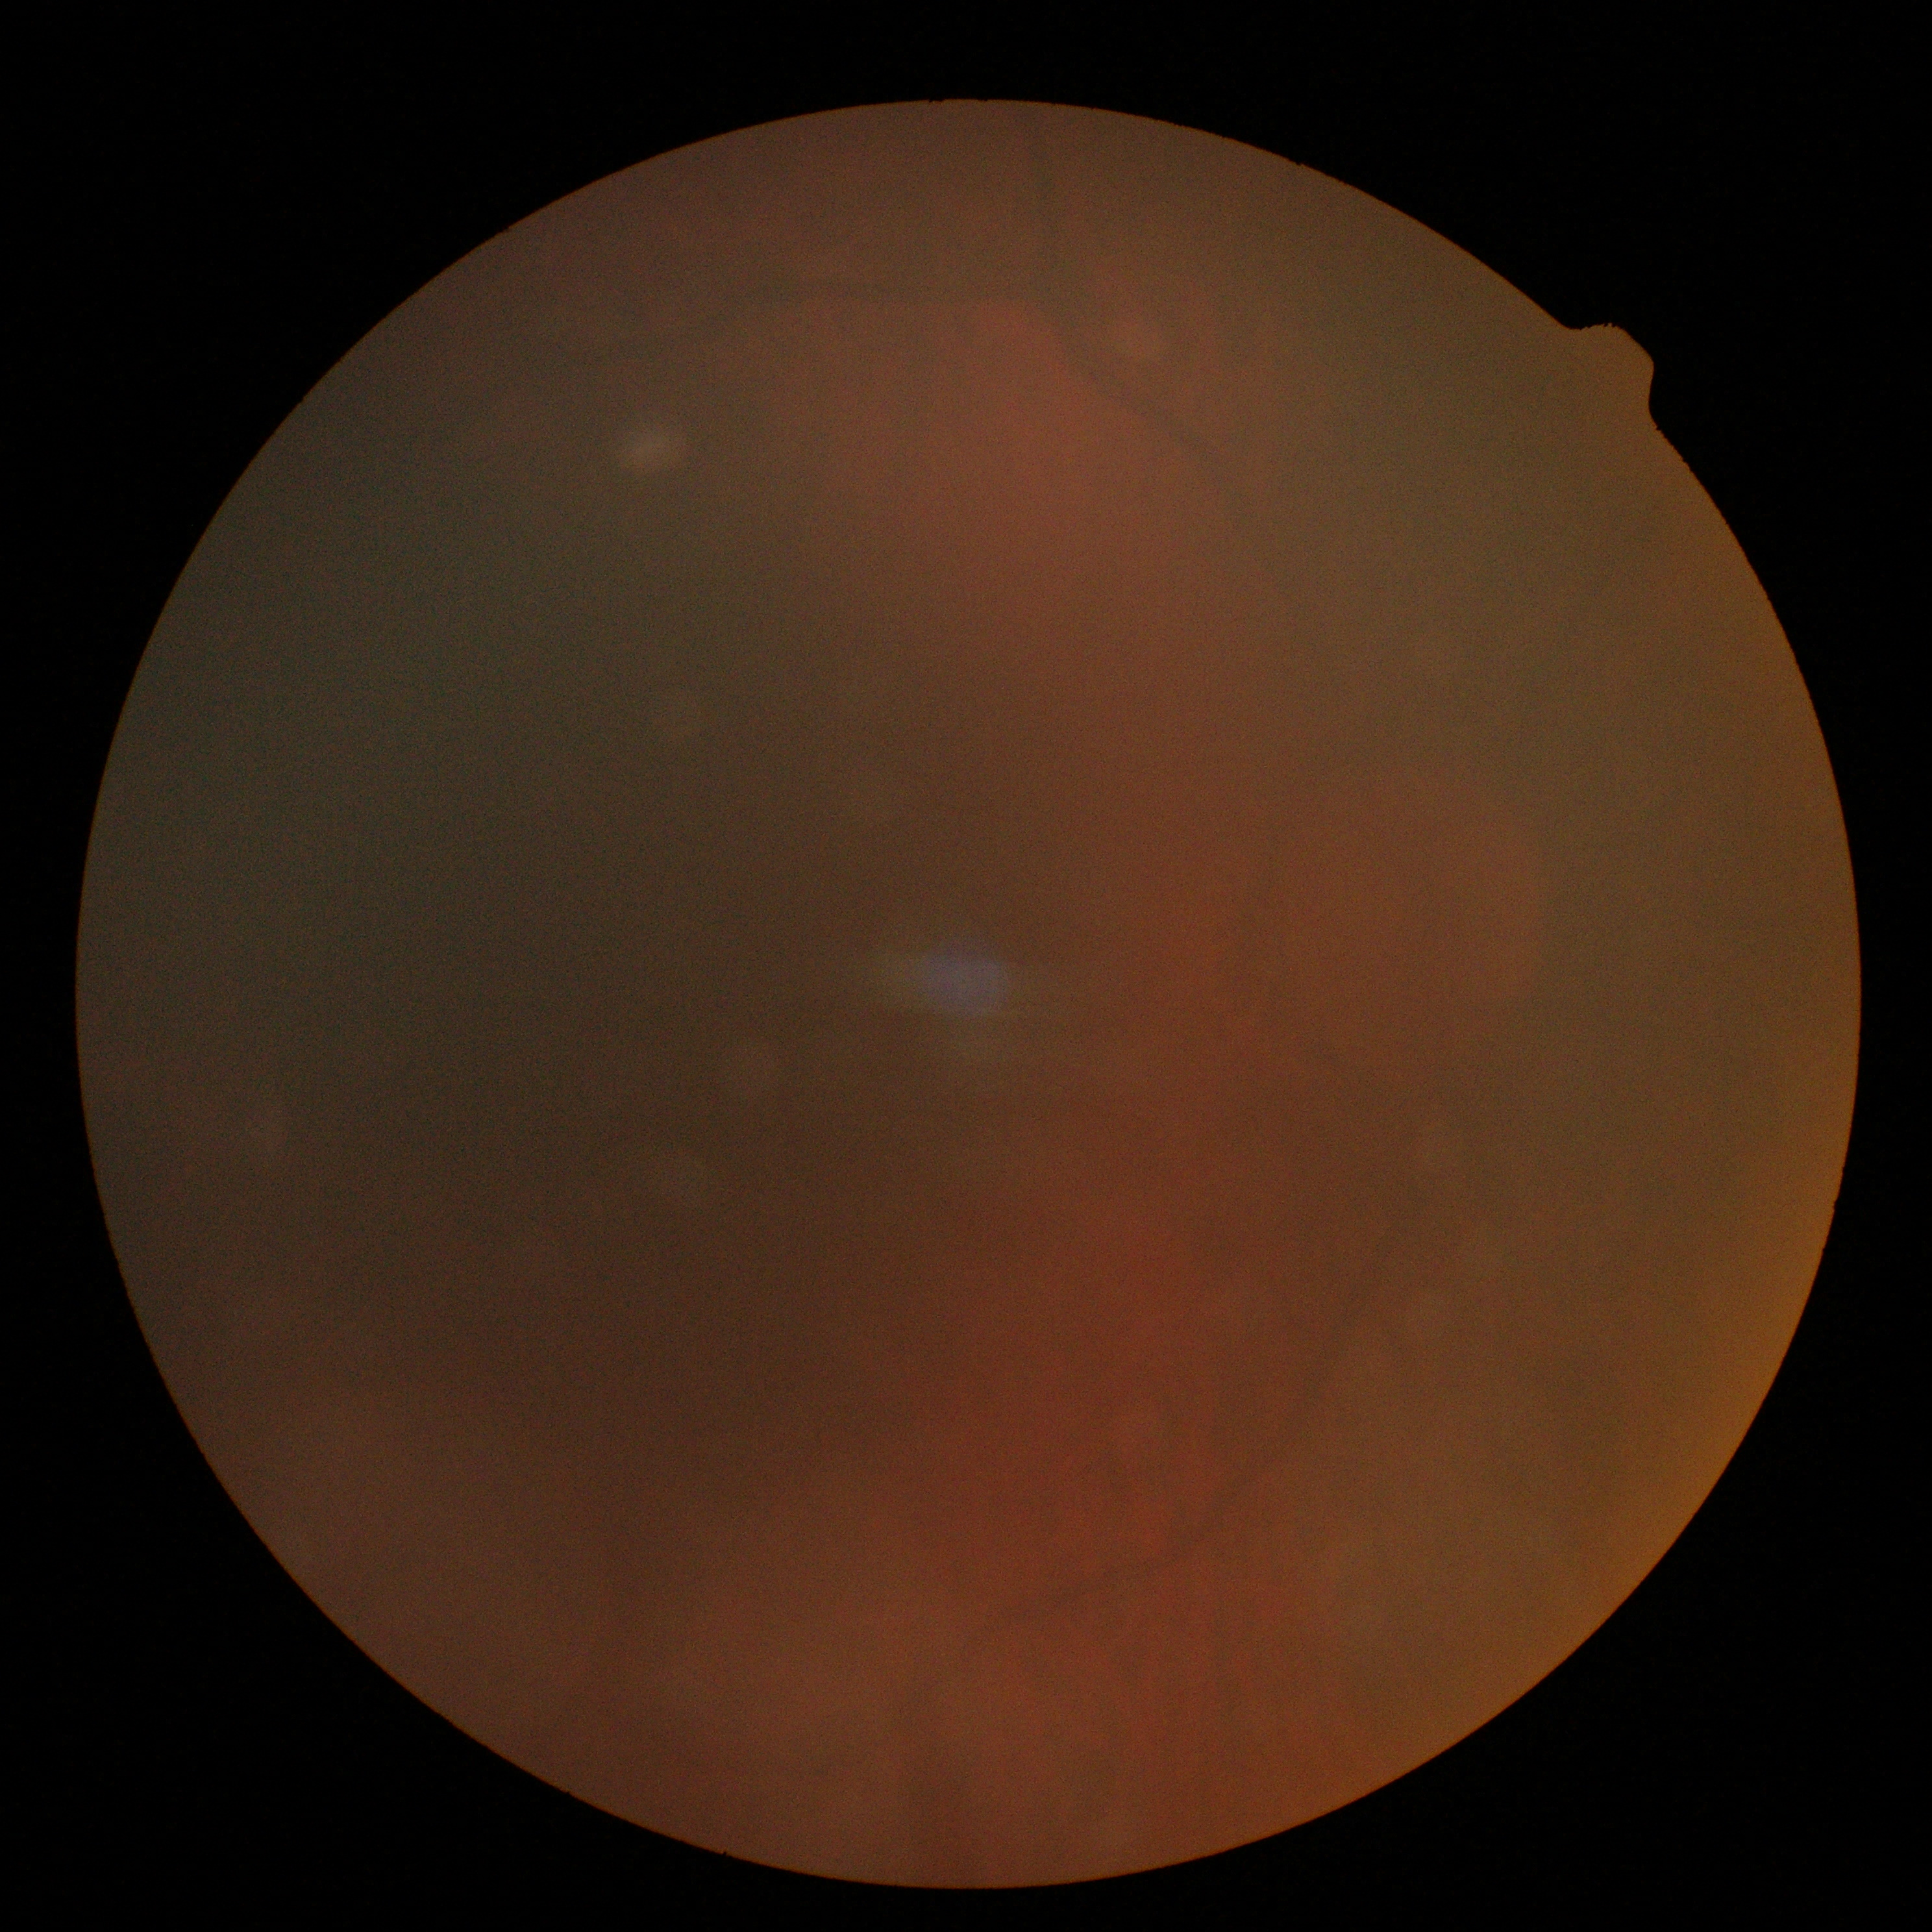
diabetic retinopathy severity: ungradable, image quality: below grading threshold.